45° field of view. Nonmydriatic. CFP:
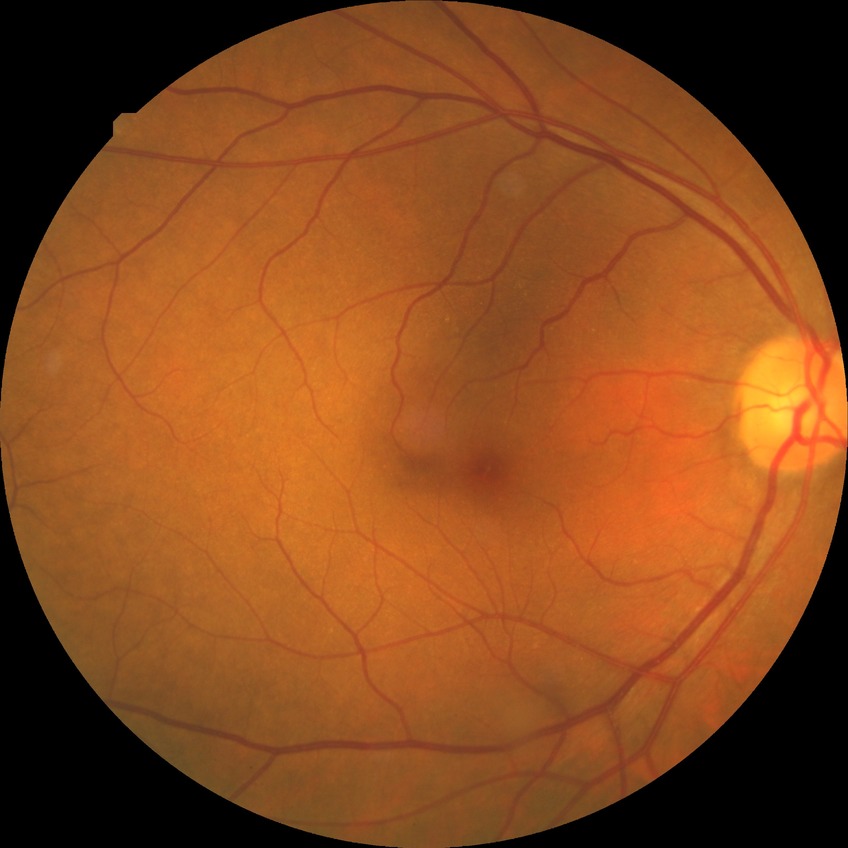
Davis grade: NDR.